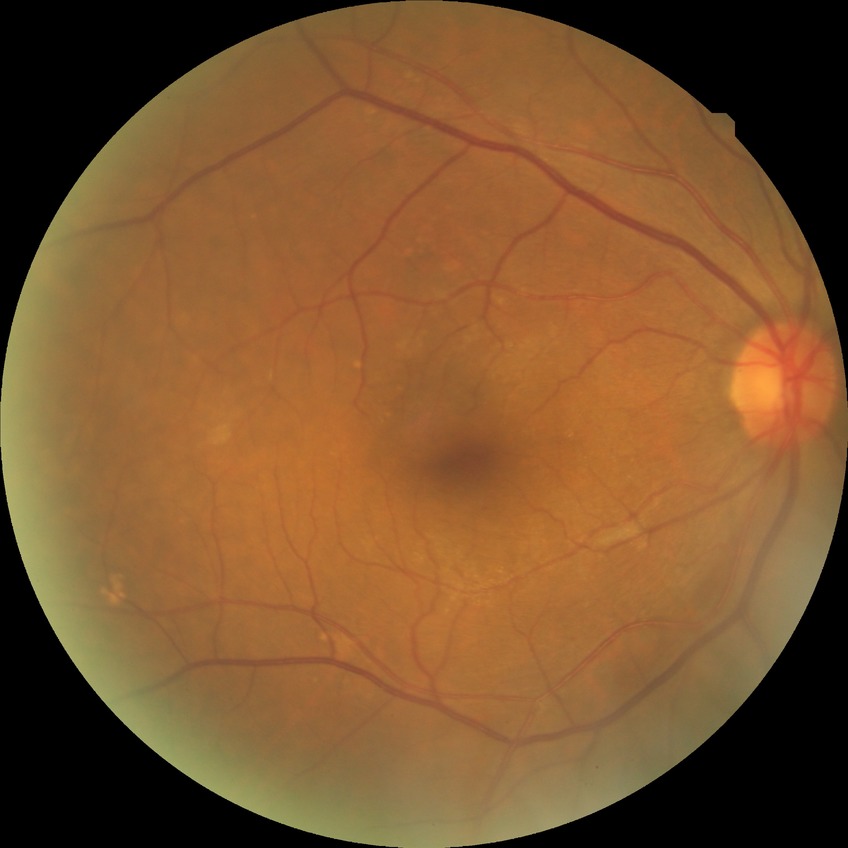

Modified Davis classification is no diabetic retinopathy.